45° field of view. Posterior pole photograph.
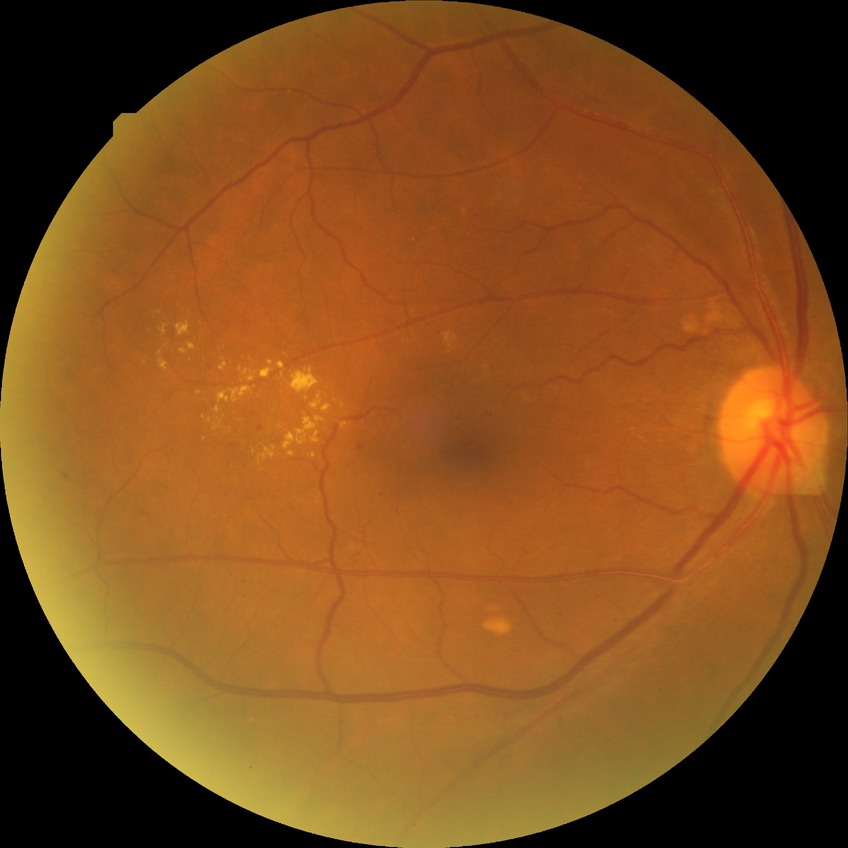 Diabetic retinopathy (DR) is SDR (simple diabetic retinopathy).